45° field of view, graded on the modified Davis scale, 848 x 848 pixels — 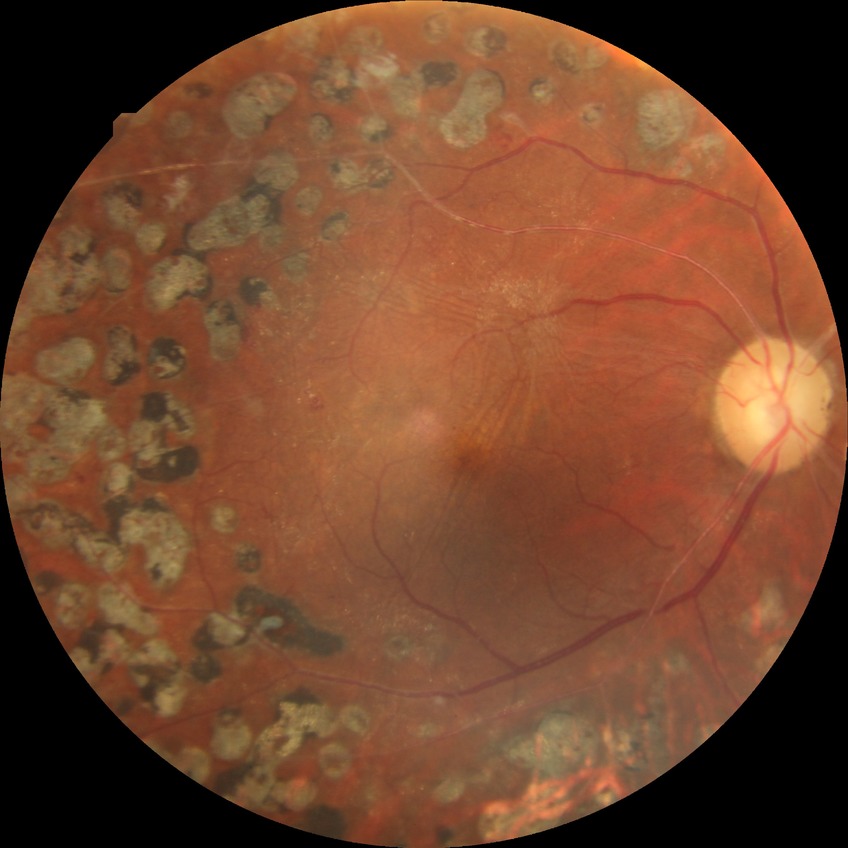 Davis grading: proliferative diabetic retinopathy.